Image size 2212x1659 · FOV: 45 degrees · fundus photo.
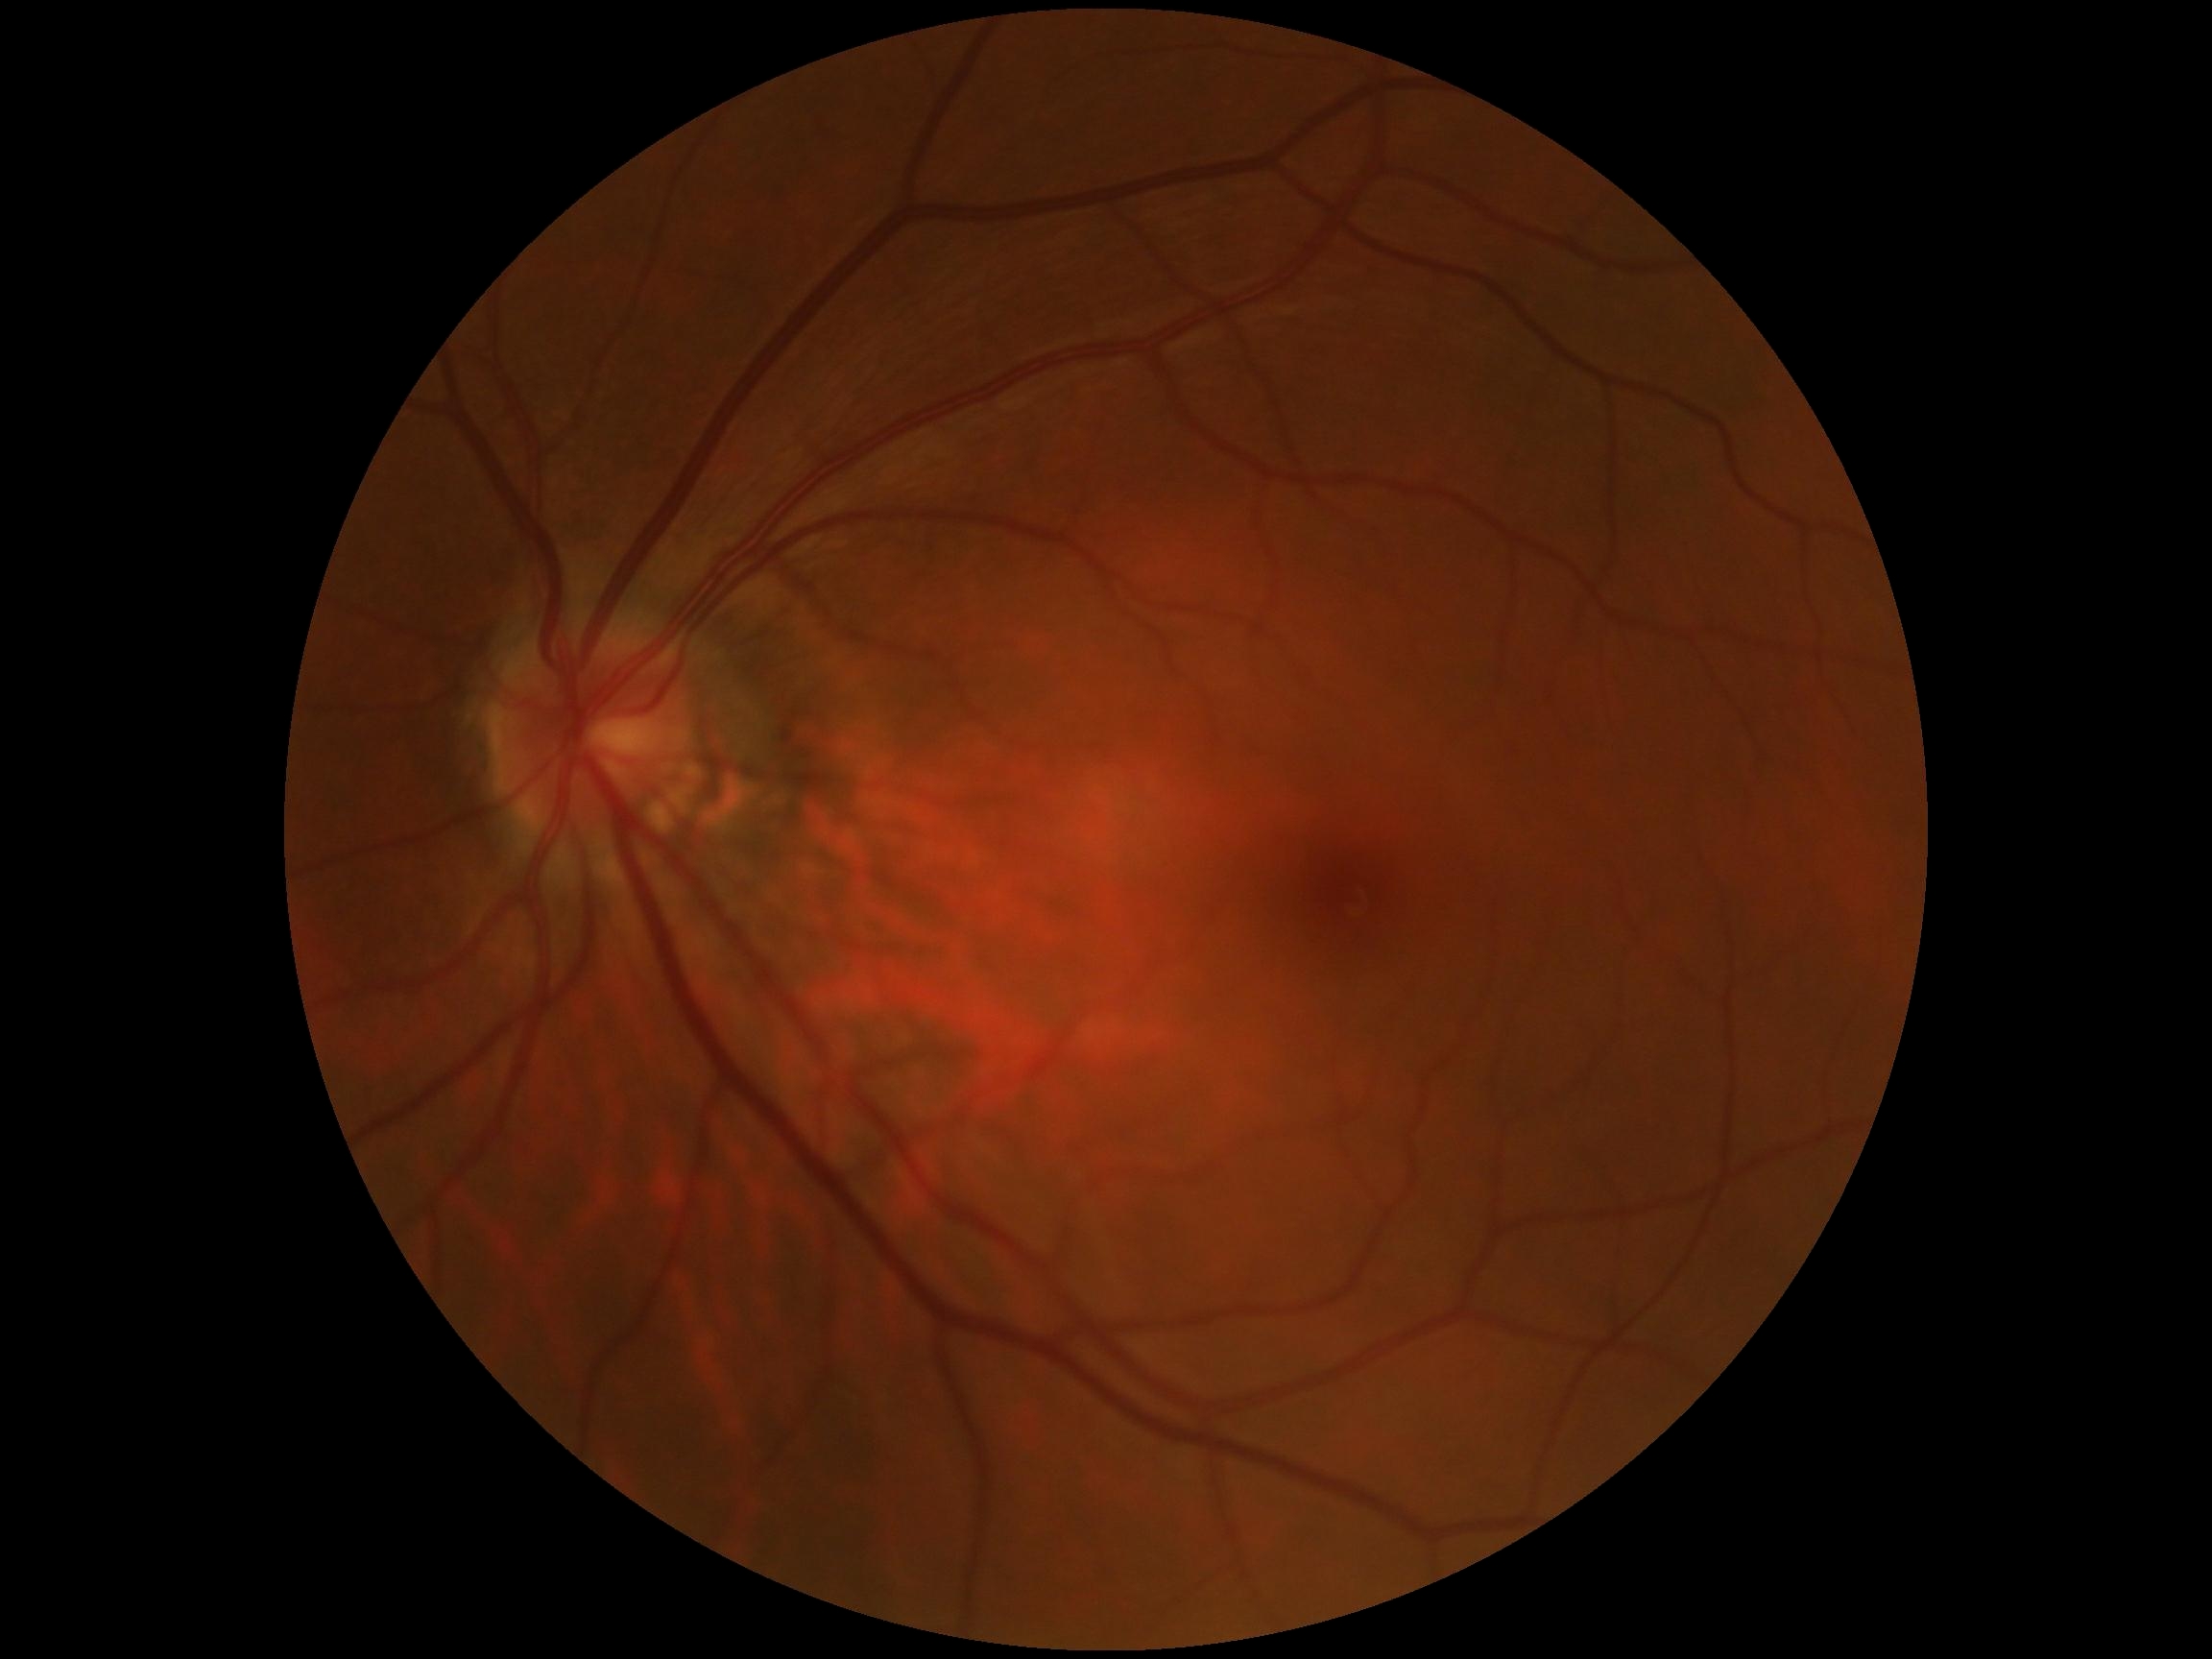

DR: 0/4 — no visible signs of diabetic retinopathy.